Captured on a Nidek AFC-330 fundus camera; retinal fundus photograph.
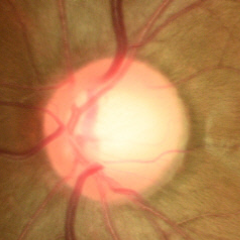

Showing no evidence of glaucoma.